FOV: 45 degrees:
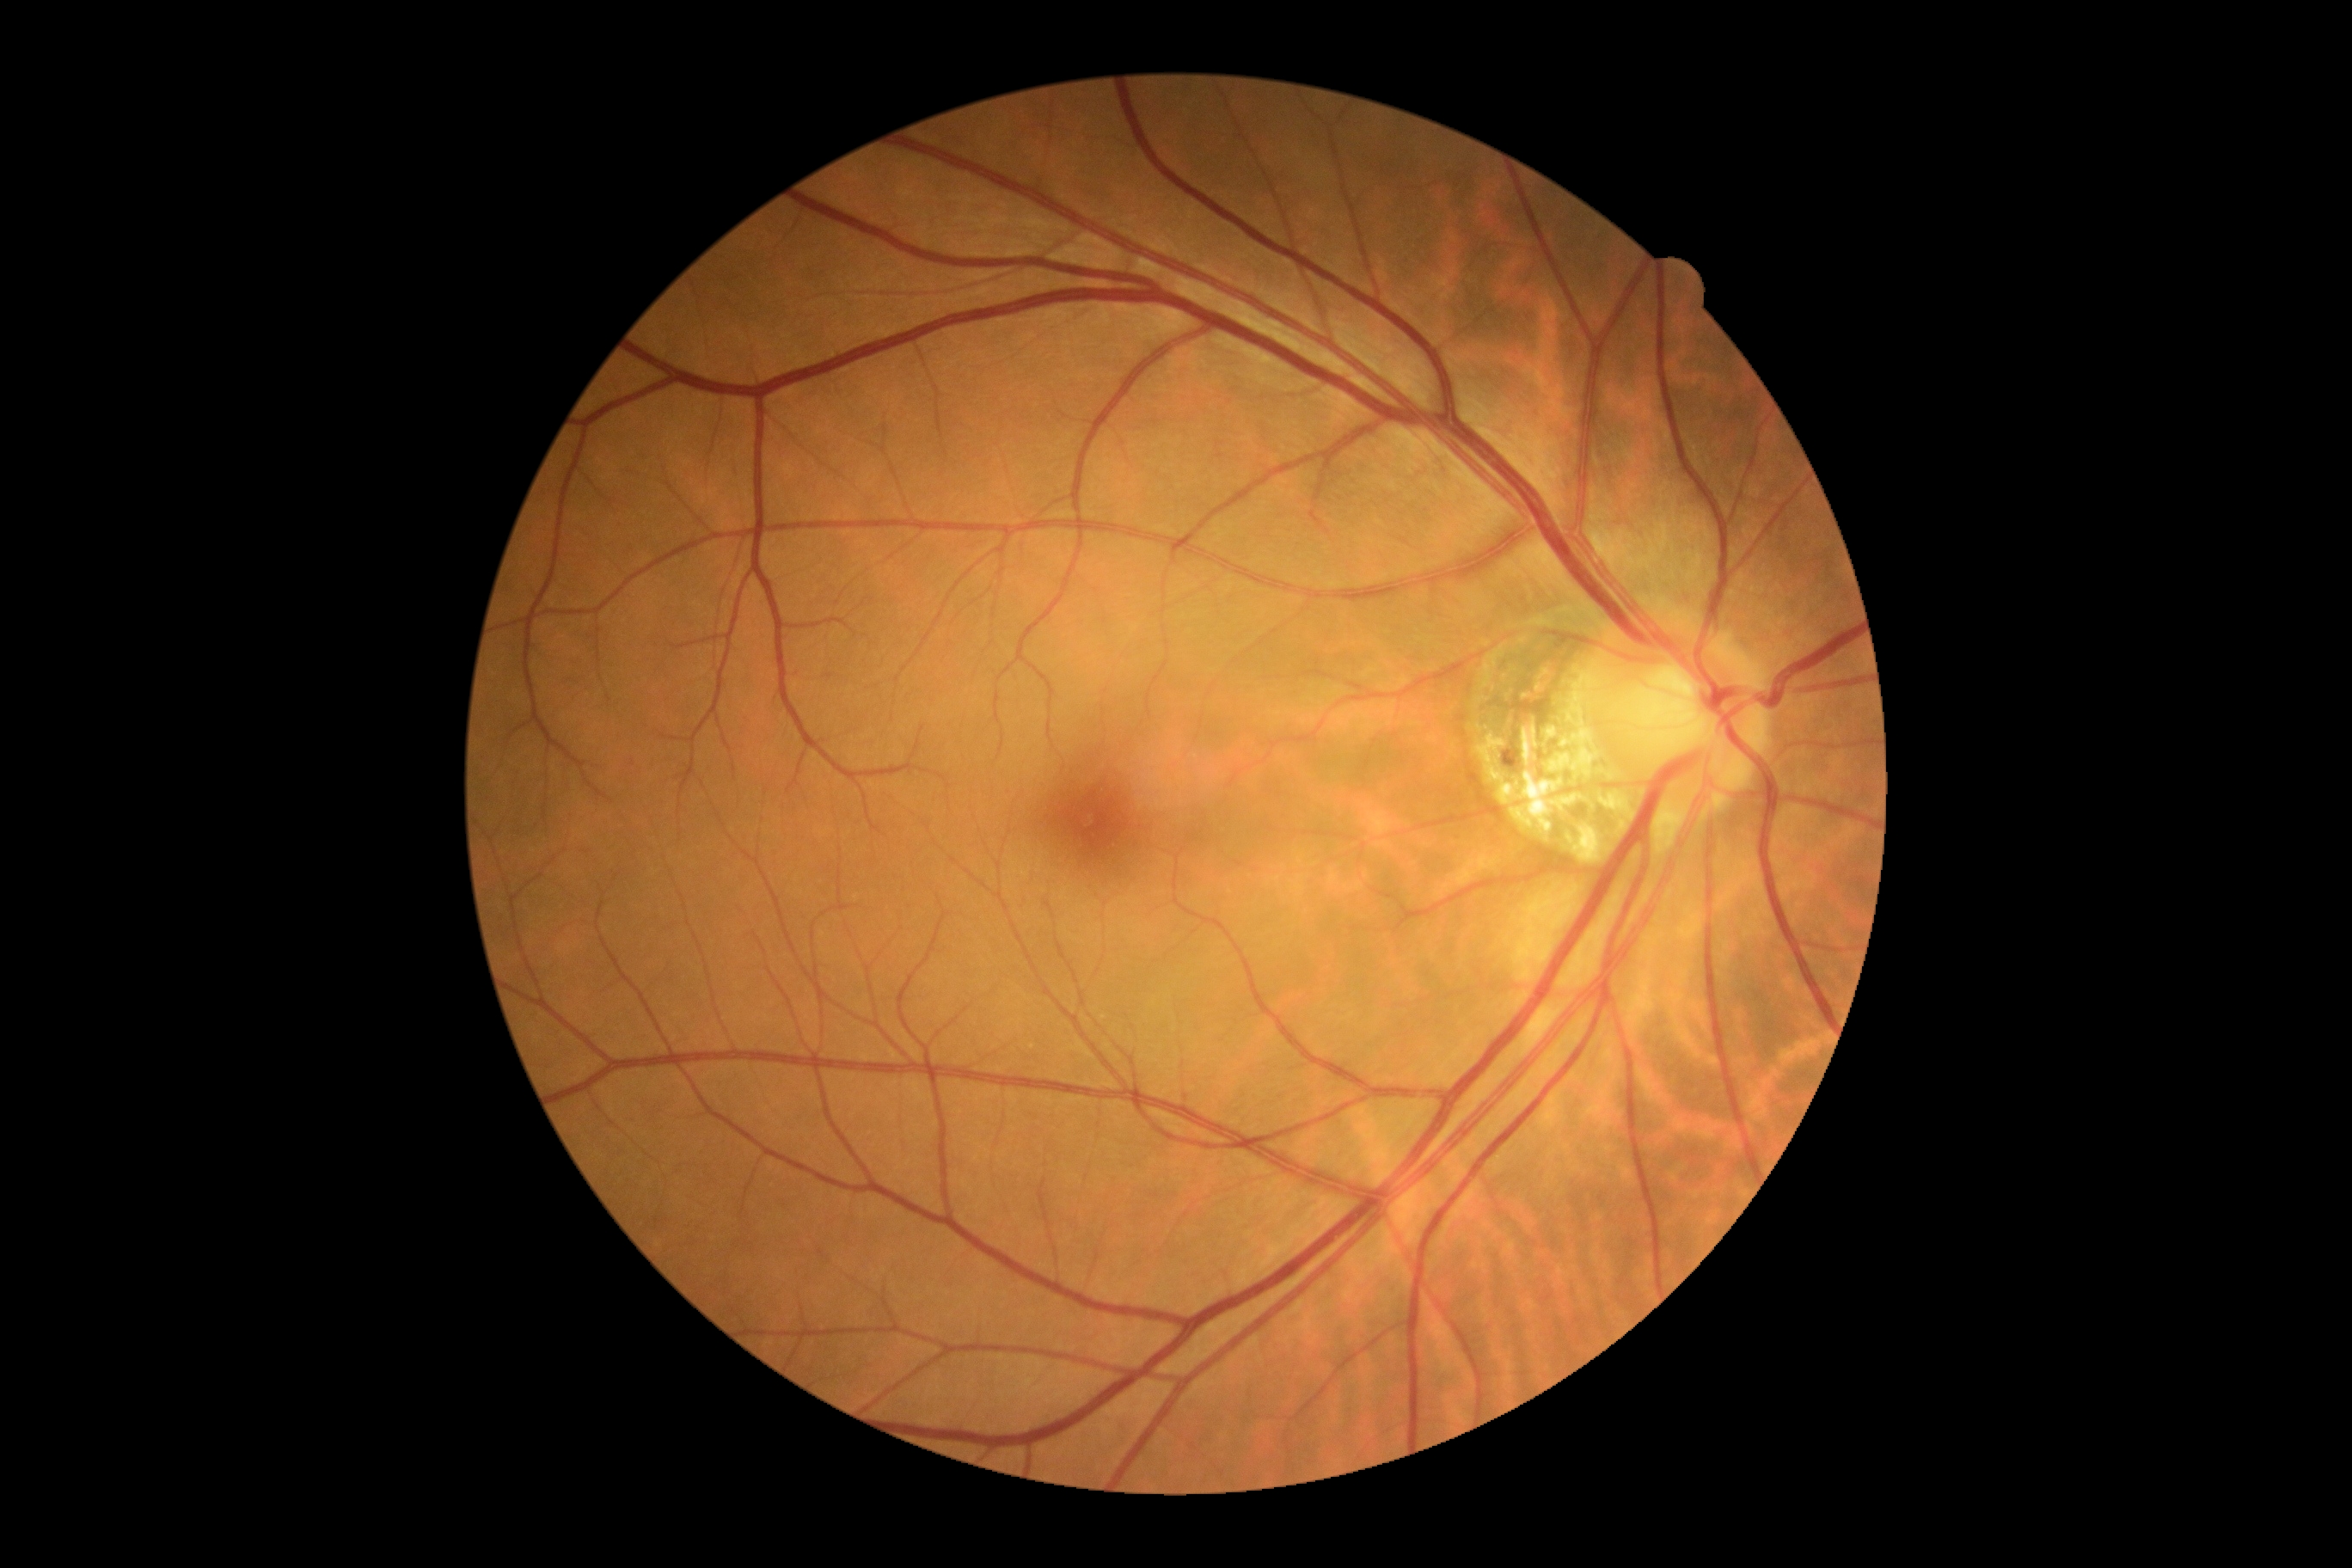 DR grade: 0/4.